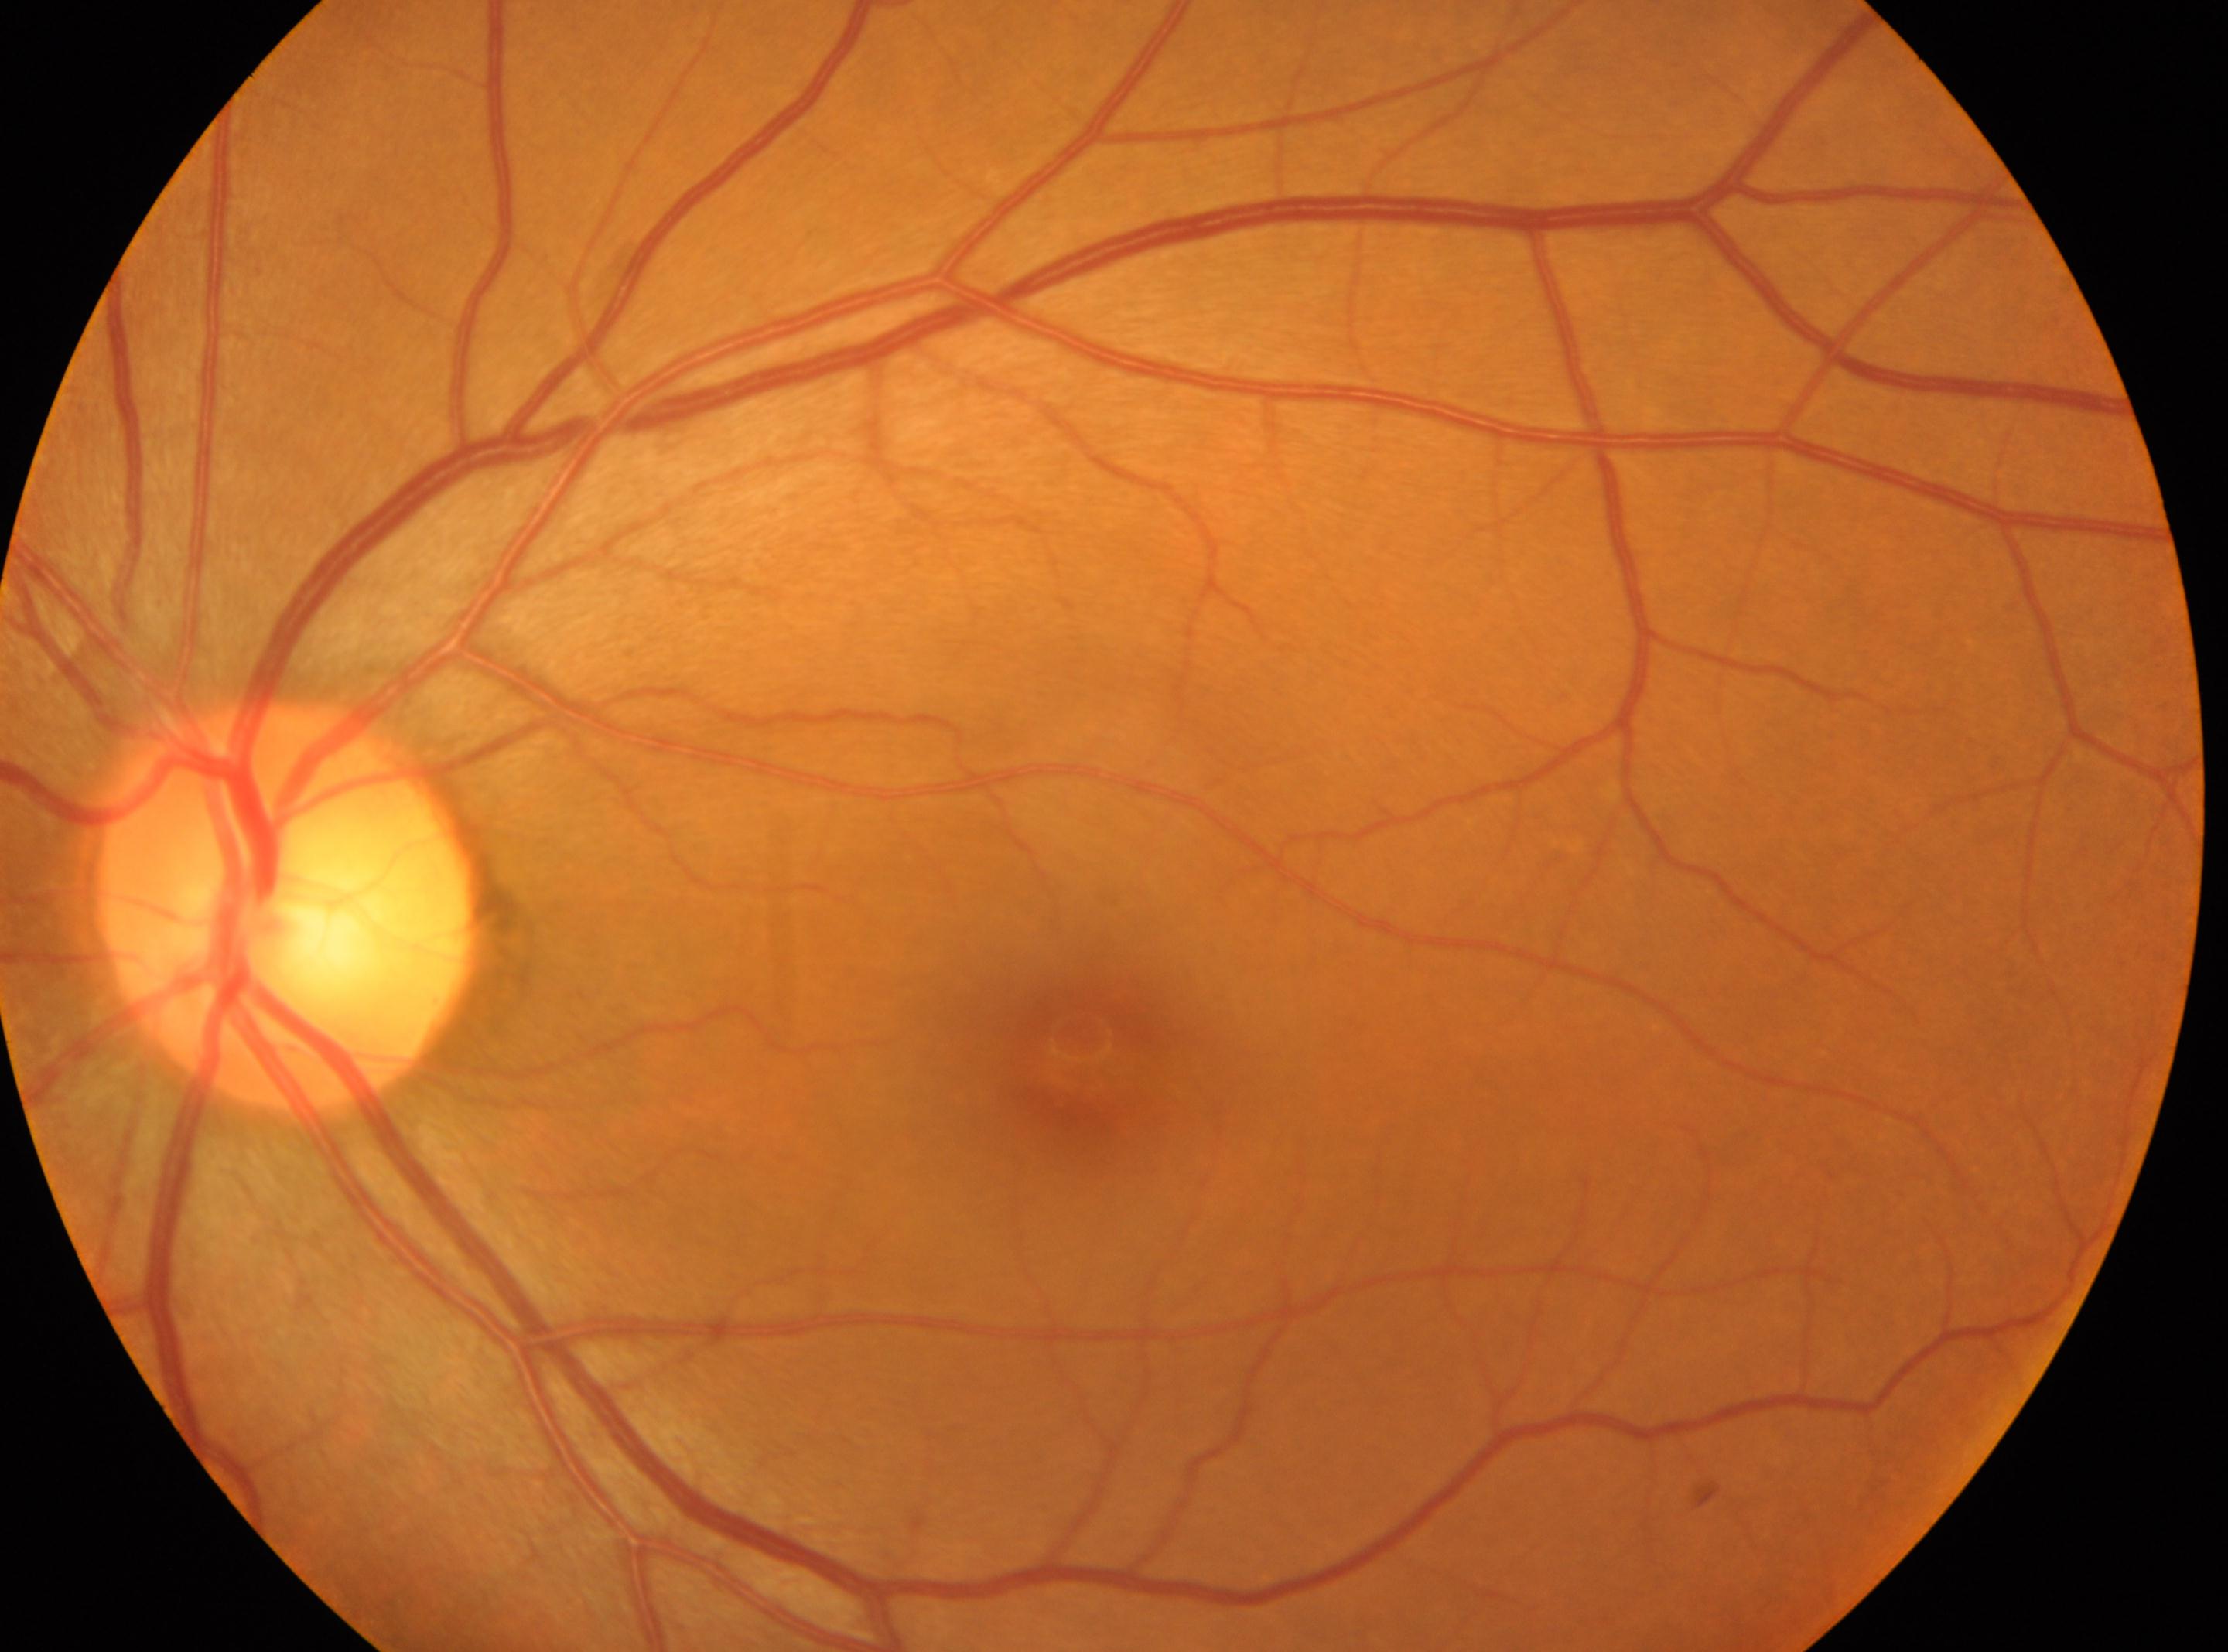 DR severity: no apparent retinopathy (grade 0). Fovea located at (x: 1082, y: 1046). The optic disc is at (x: 287, y: 906). Eye: the left eye. No diabetic retinopathy identified.